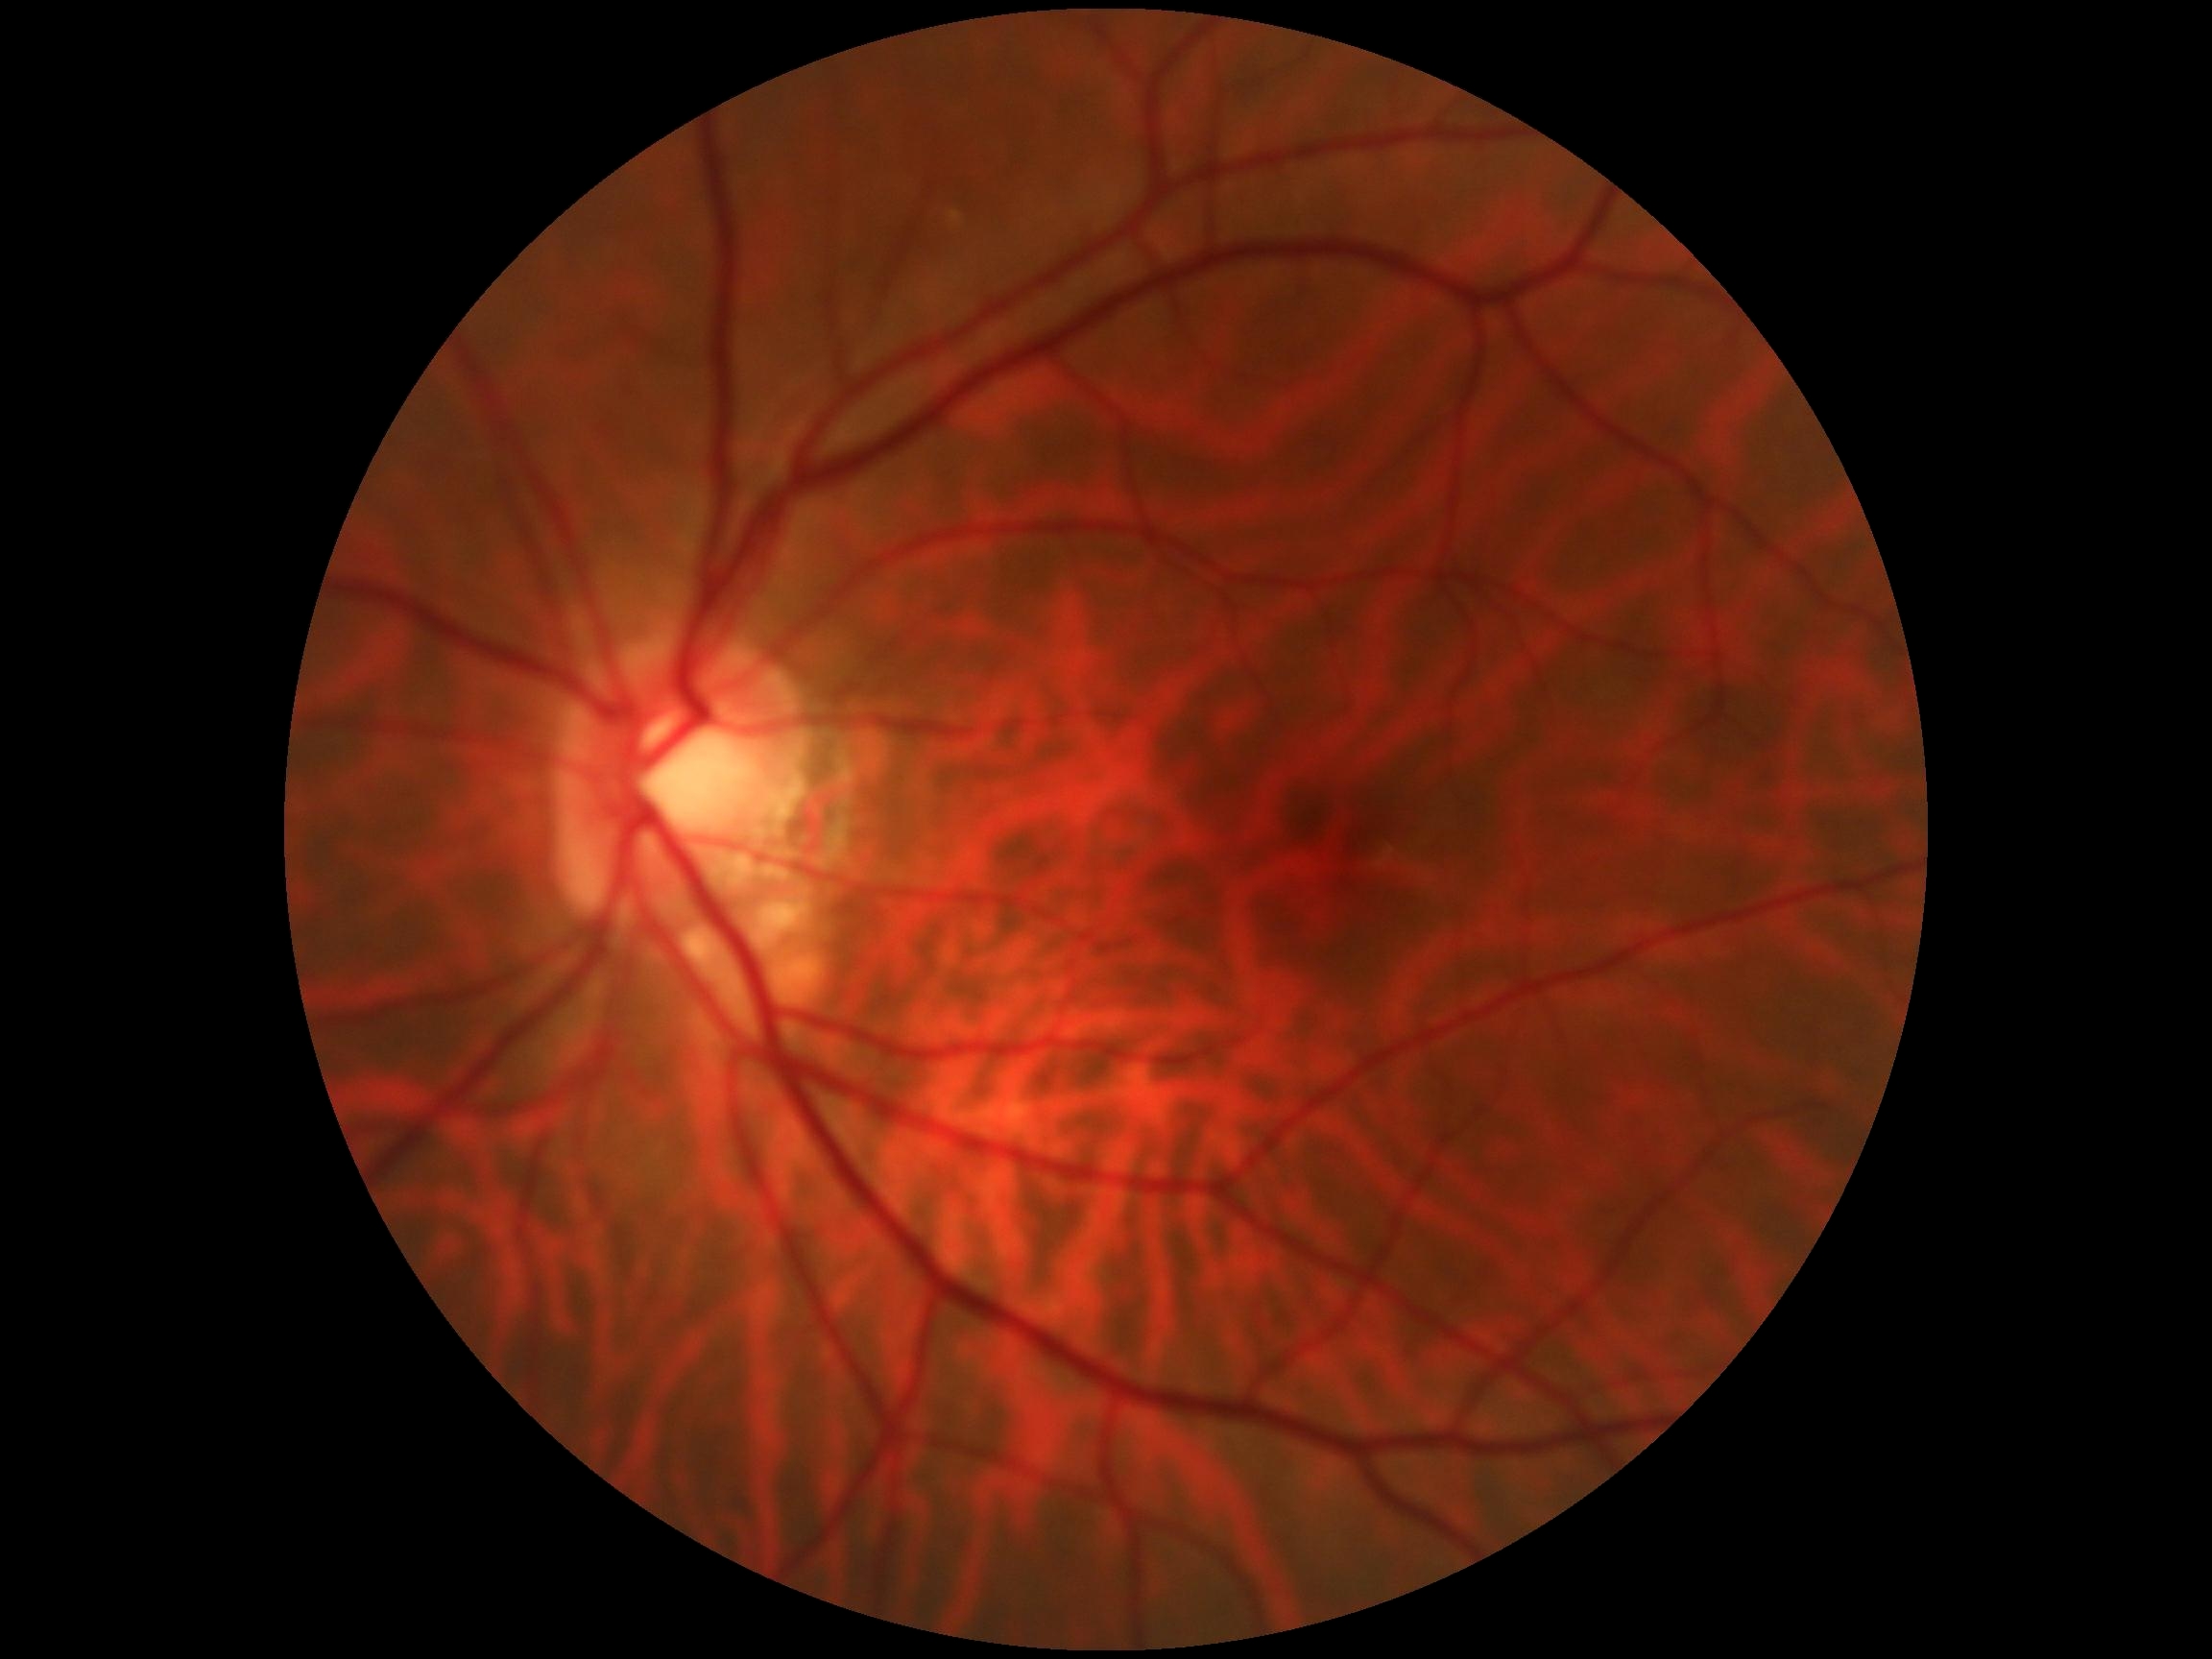

* DR grade — 0 — no visible signs of diabetic retinopathy
* DR impression — no DR findings